2352x1568px. CFP:
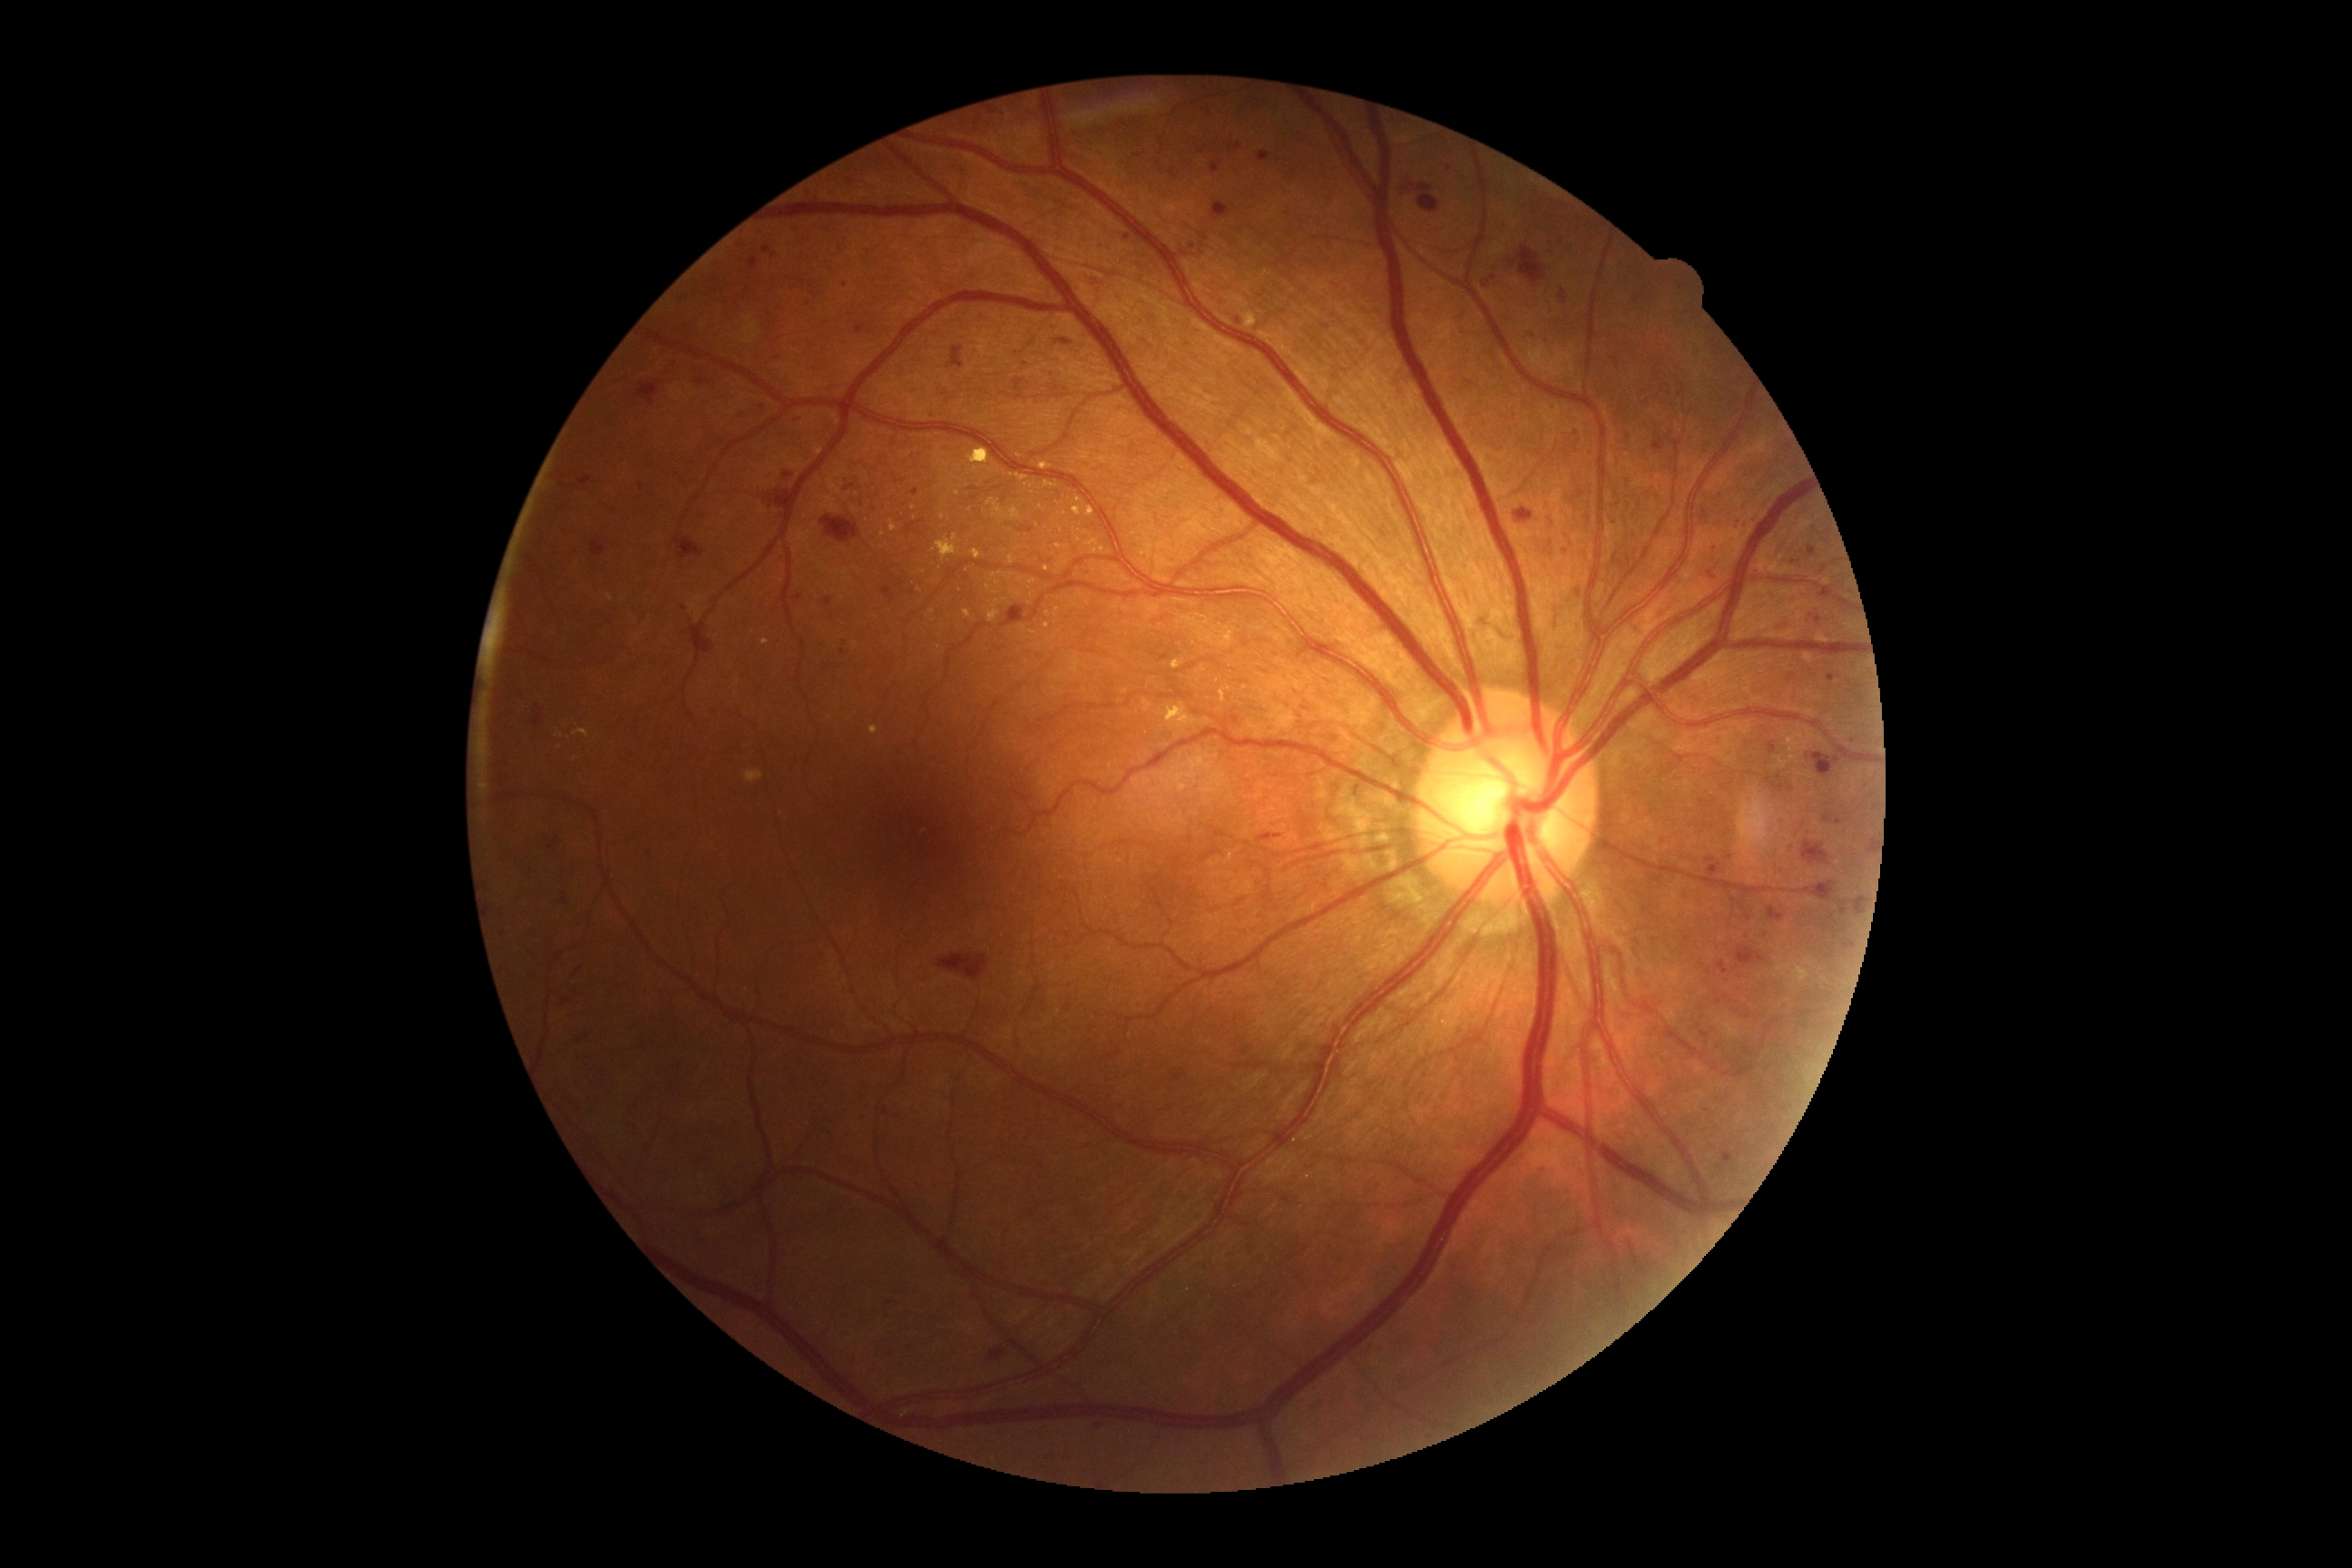

Diabetic retinopathy (DR): 2/4
A subset of detected lesions:
microaneurysms (MAs) (more not shown): rect(749, 257, 760, 270); rect(580, 476, 593, 485); rect(1712, 740, 1718, 749); rect(562, 997, 569, 1006); rect(1211, 161, 1224, 173); rect(825, 598, 834, 609); rect(1836, 899, 1848, 916)
Small MAs near (1580, 592); (1404, 189); (1729, 857); (915, 492); (1056, 389); (1747, 523); (1470, 383); (1748, 1016); (763, 407); (1099, 1426)